2212x1678: 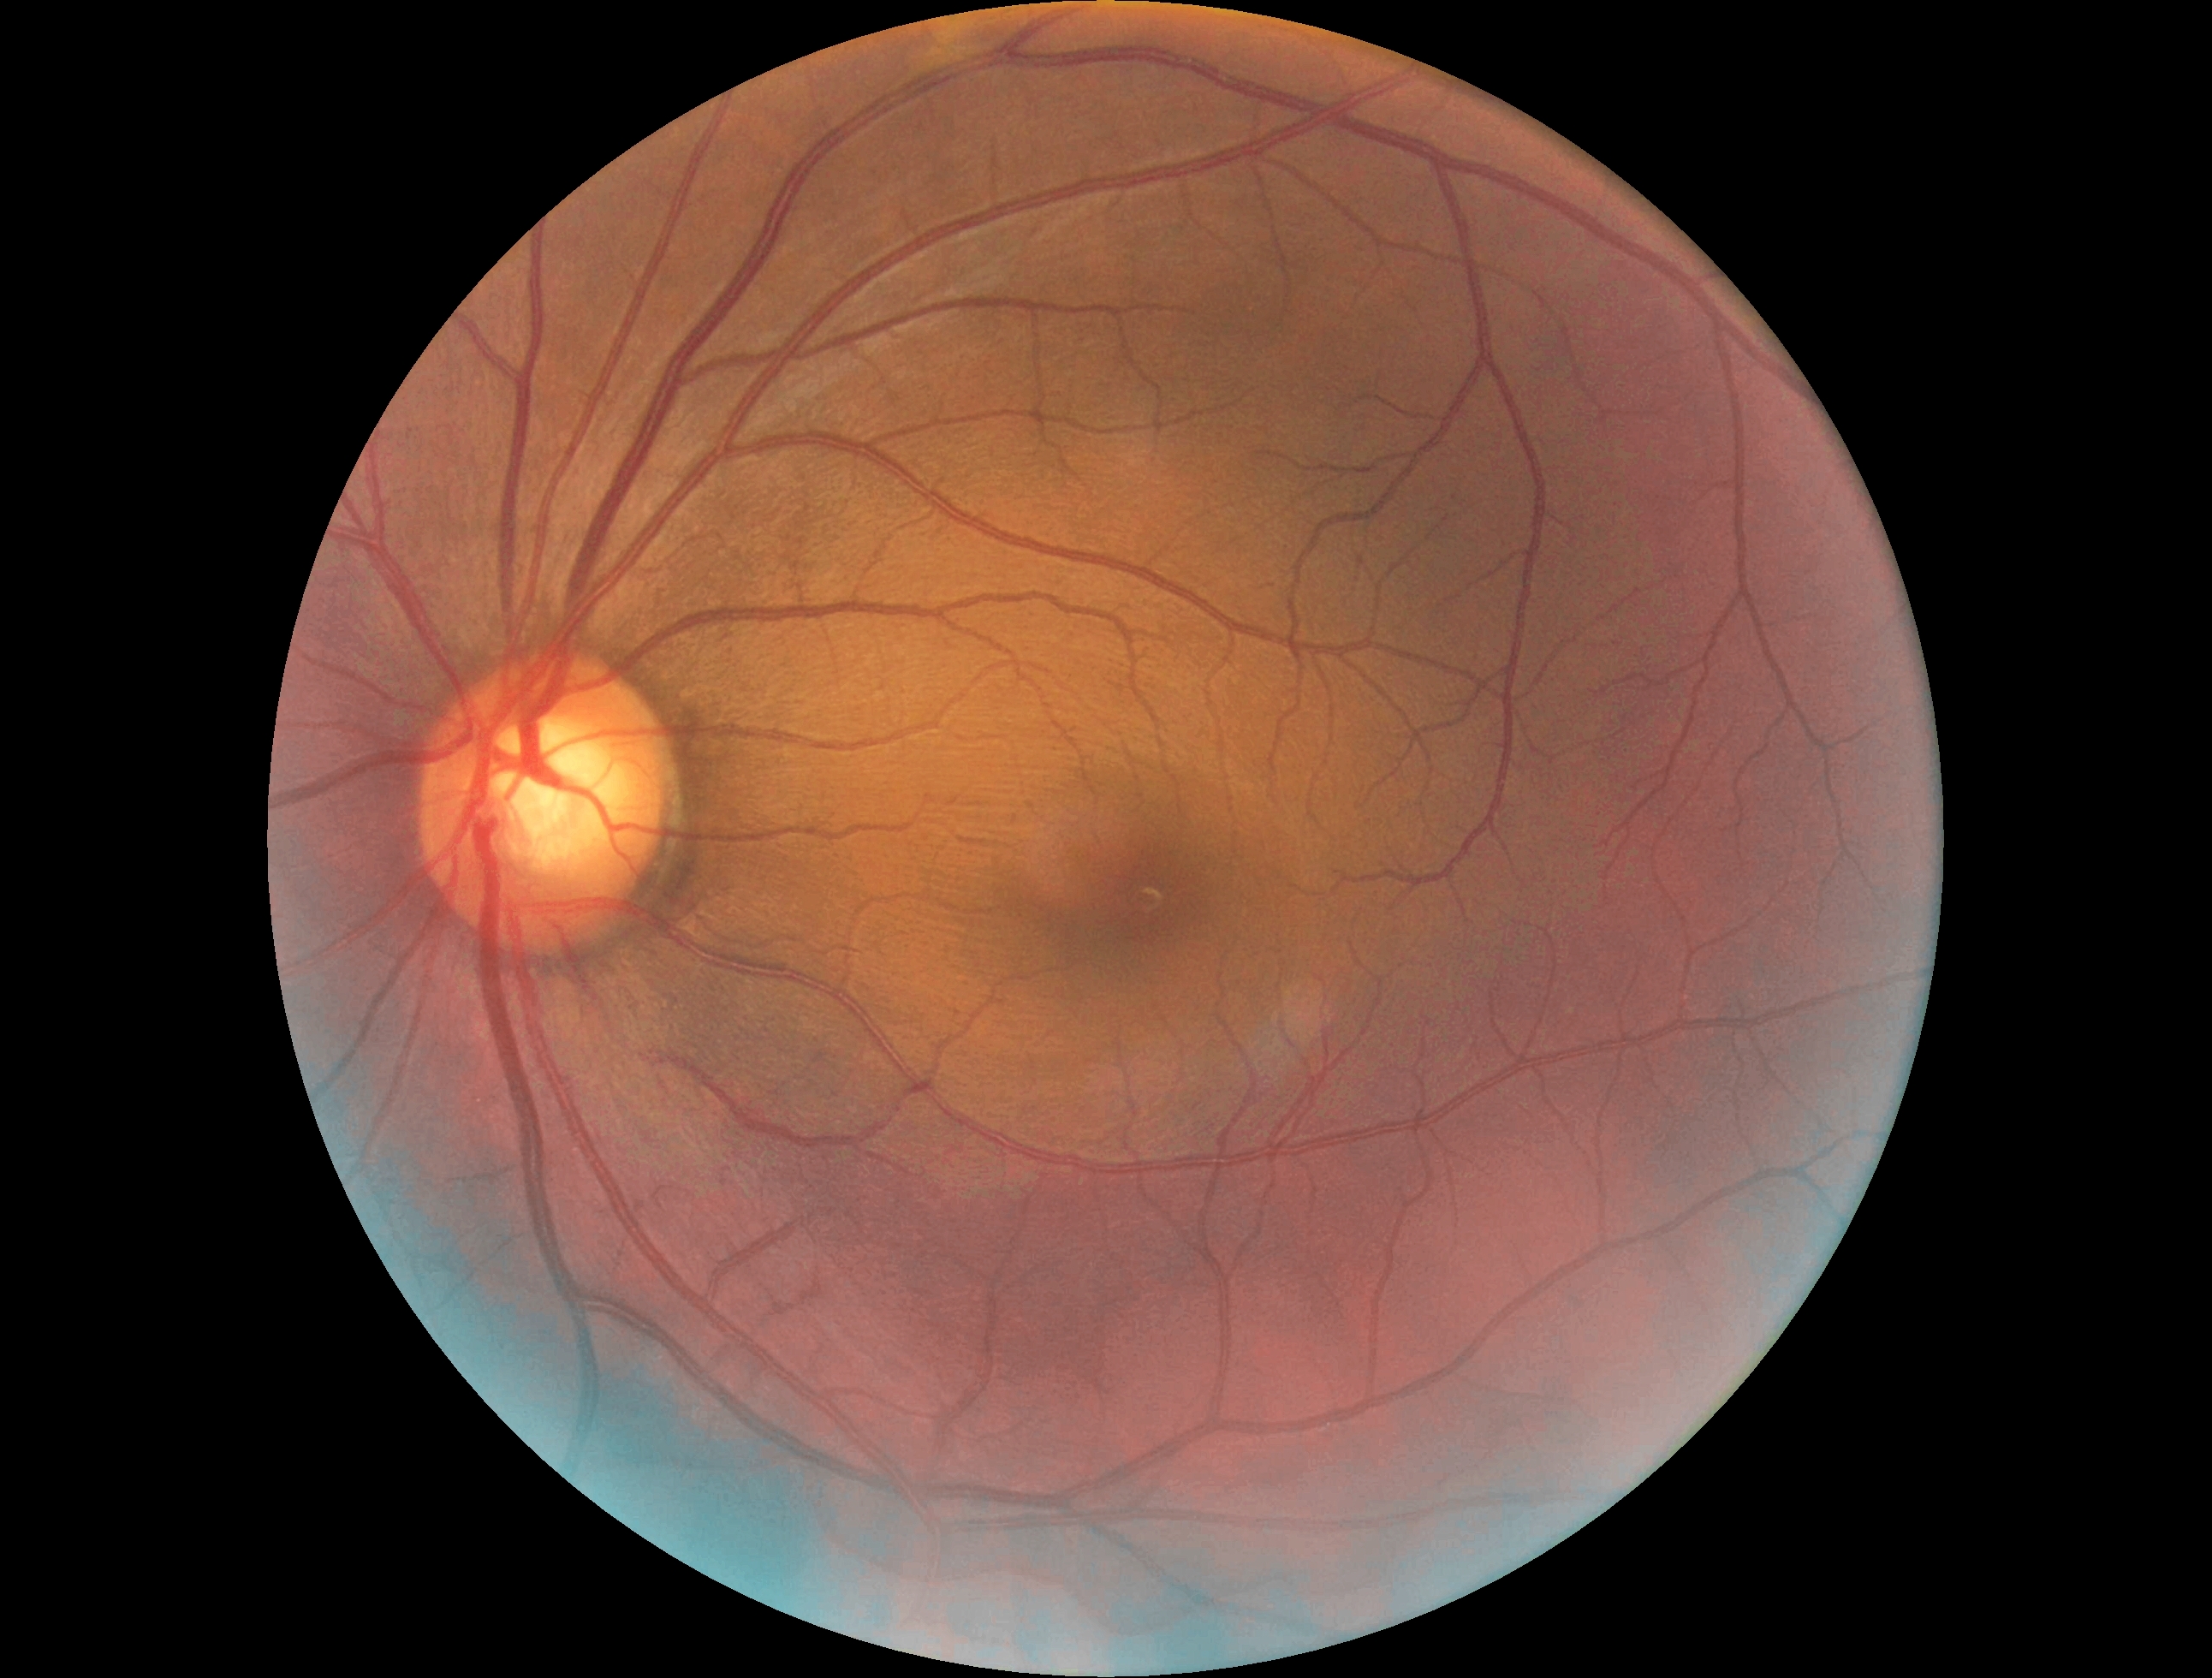
No DR findings. Diabetic retinopathy (DR): 0.